2212 x 1659 pixels:
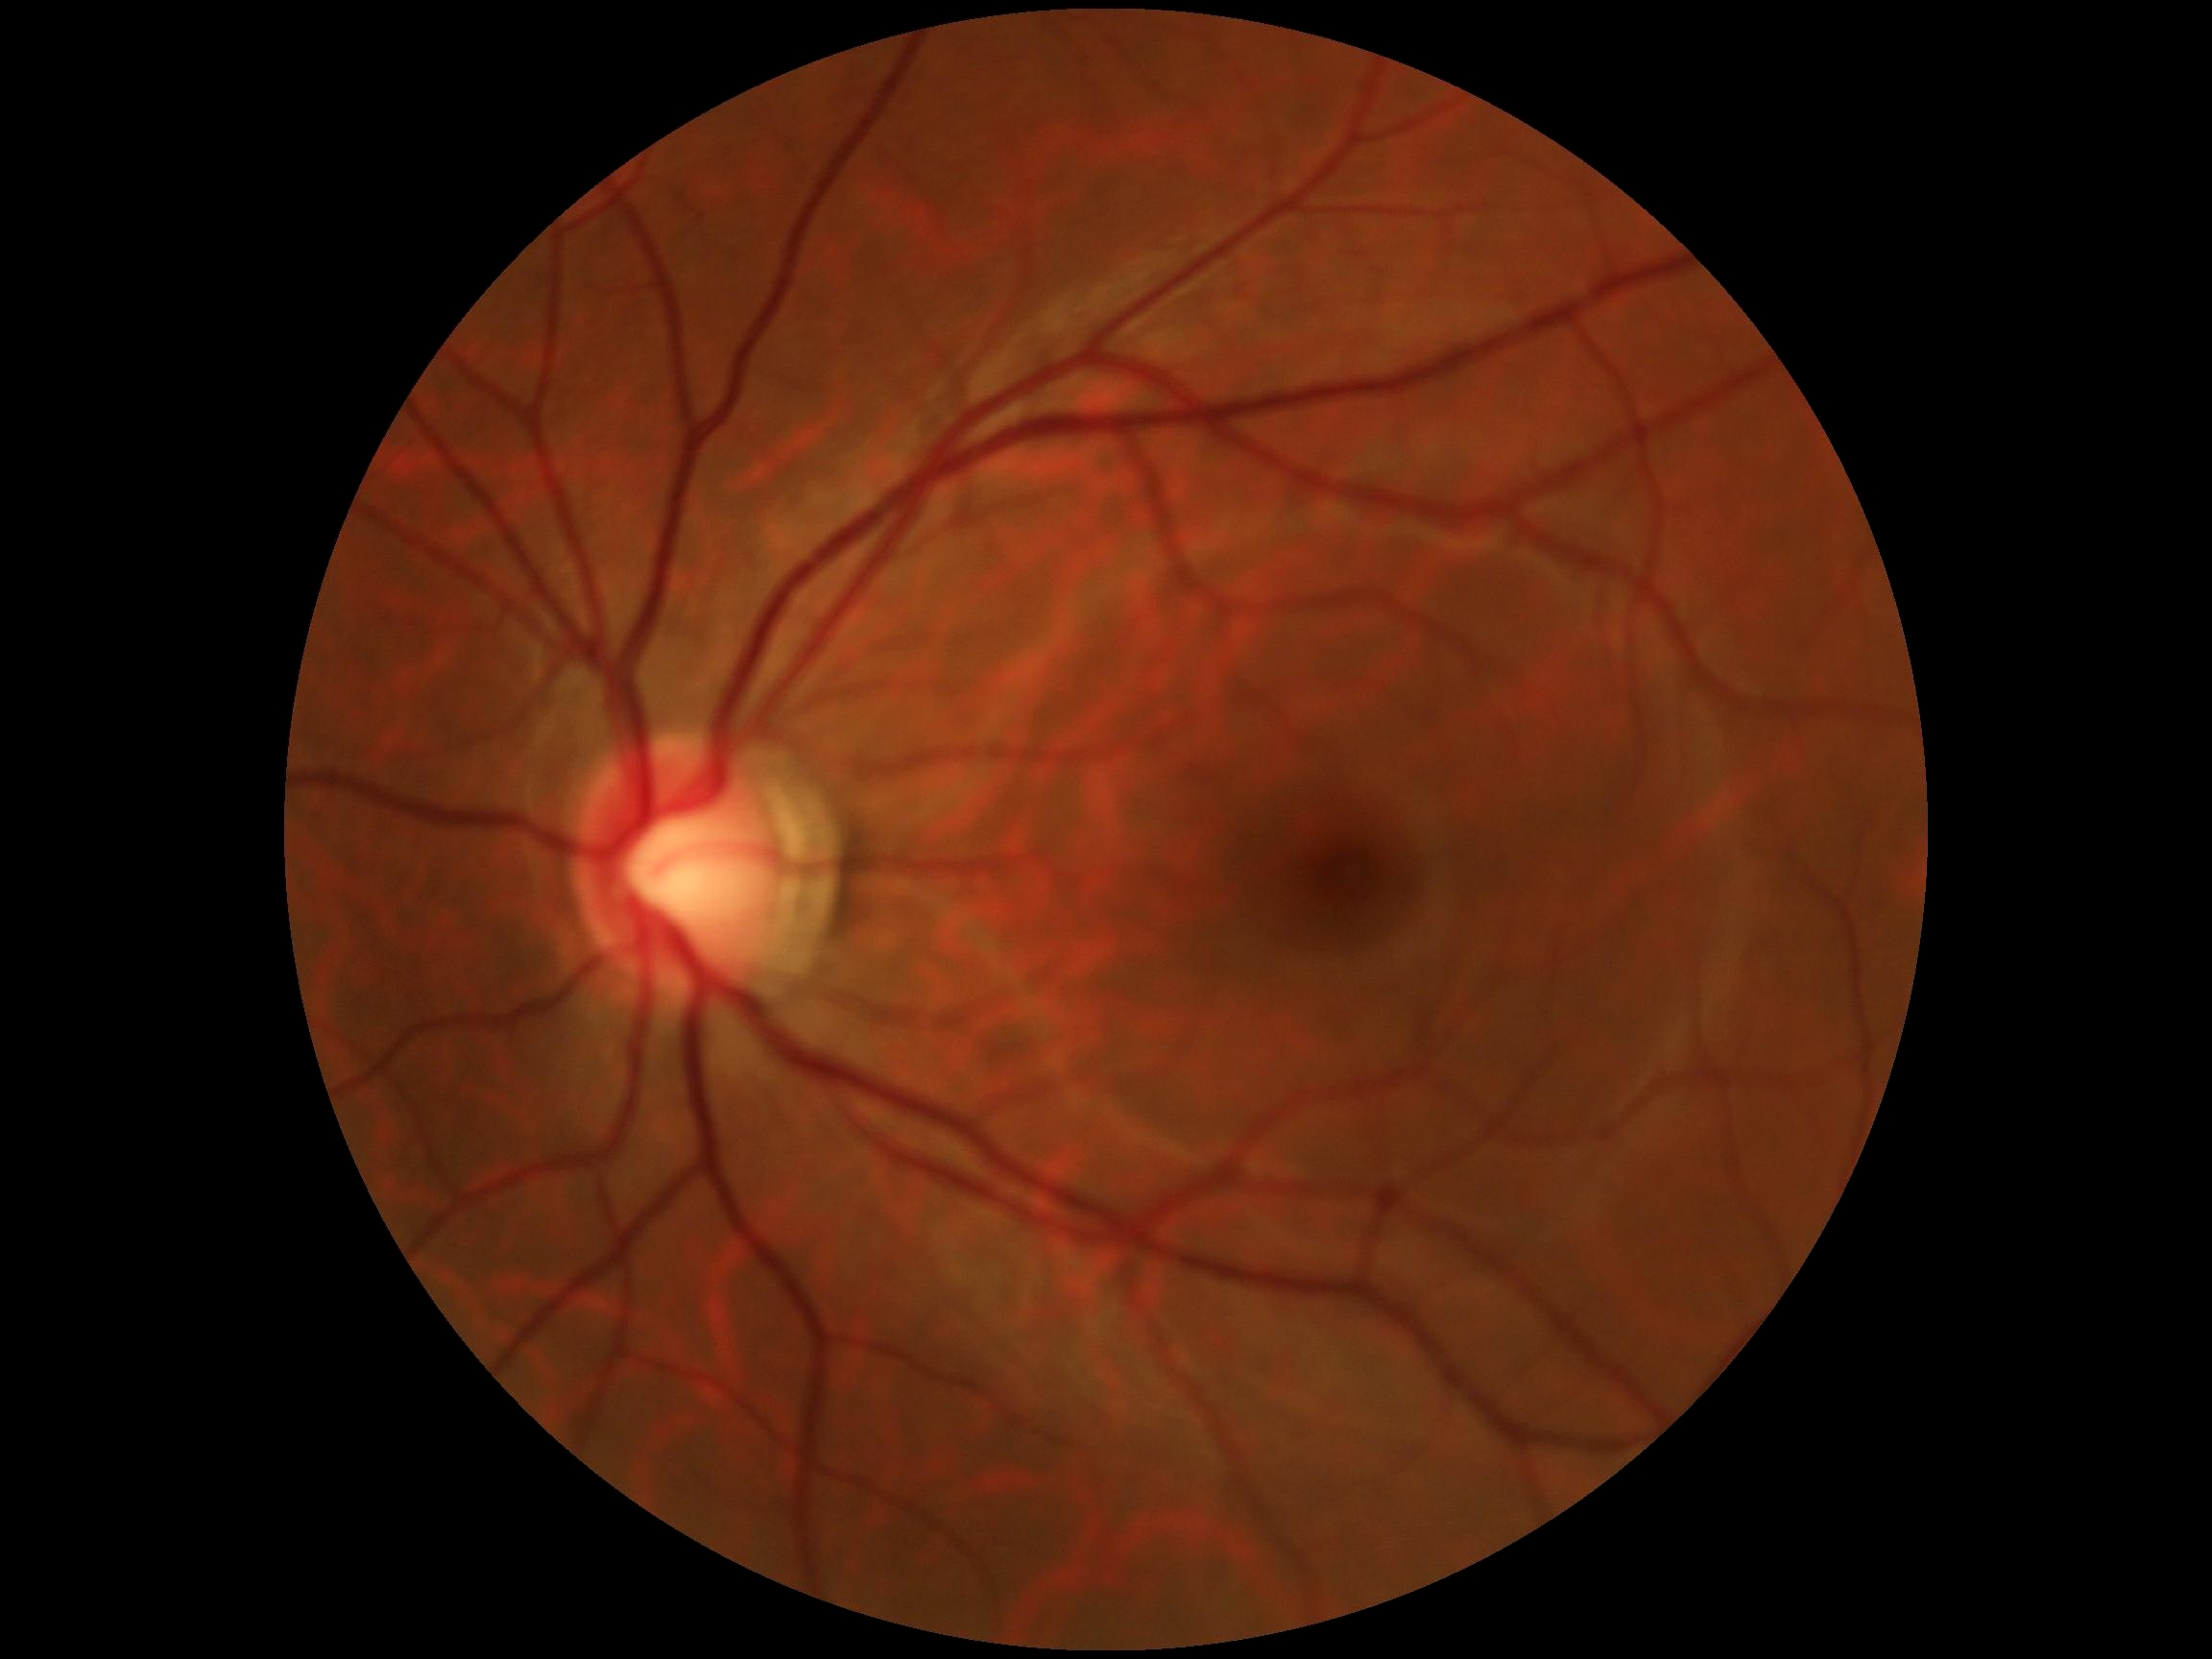
DR stage: 0.